1240 x 1240 pixels. Pediatric wide-field fundus photograph. Captured with the Phoenix ICON (100° field of view):
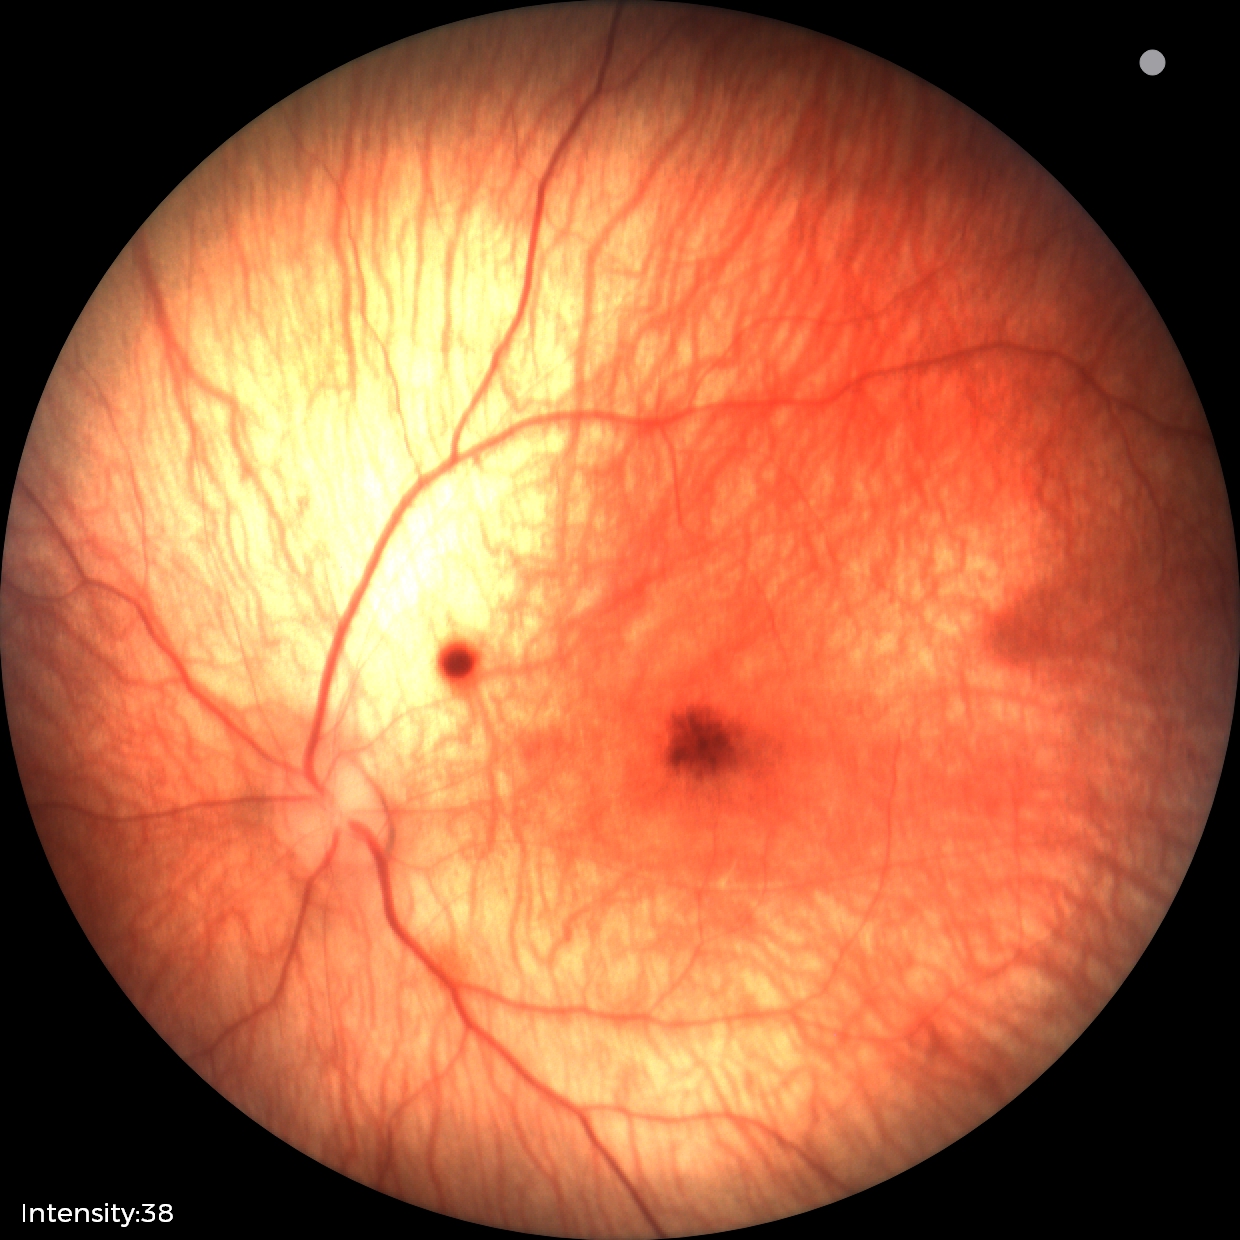 Series diagnosed as retinal hemorrhages.